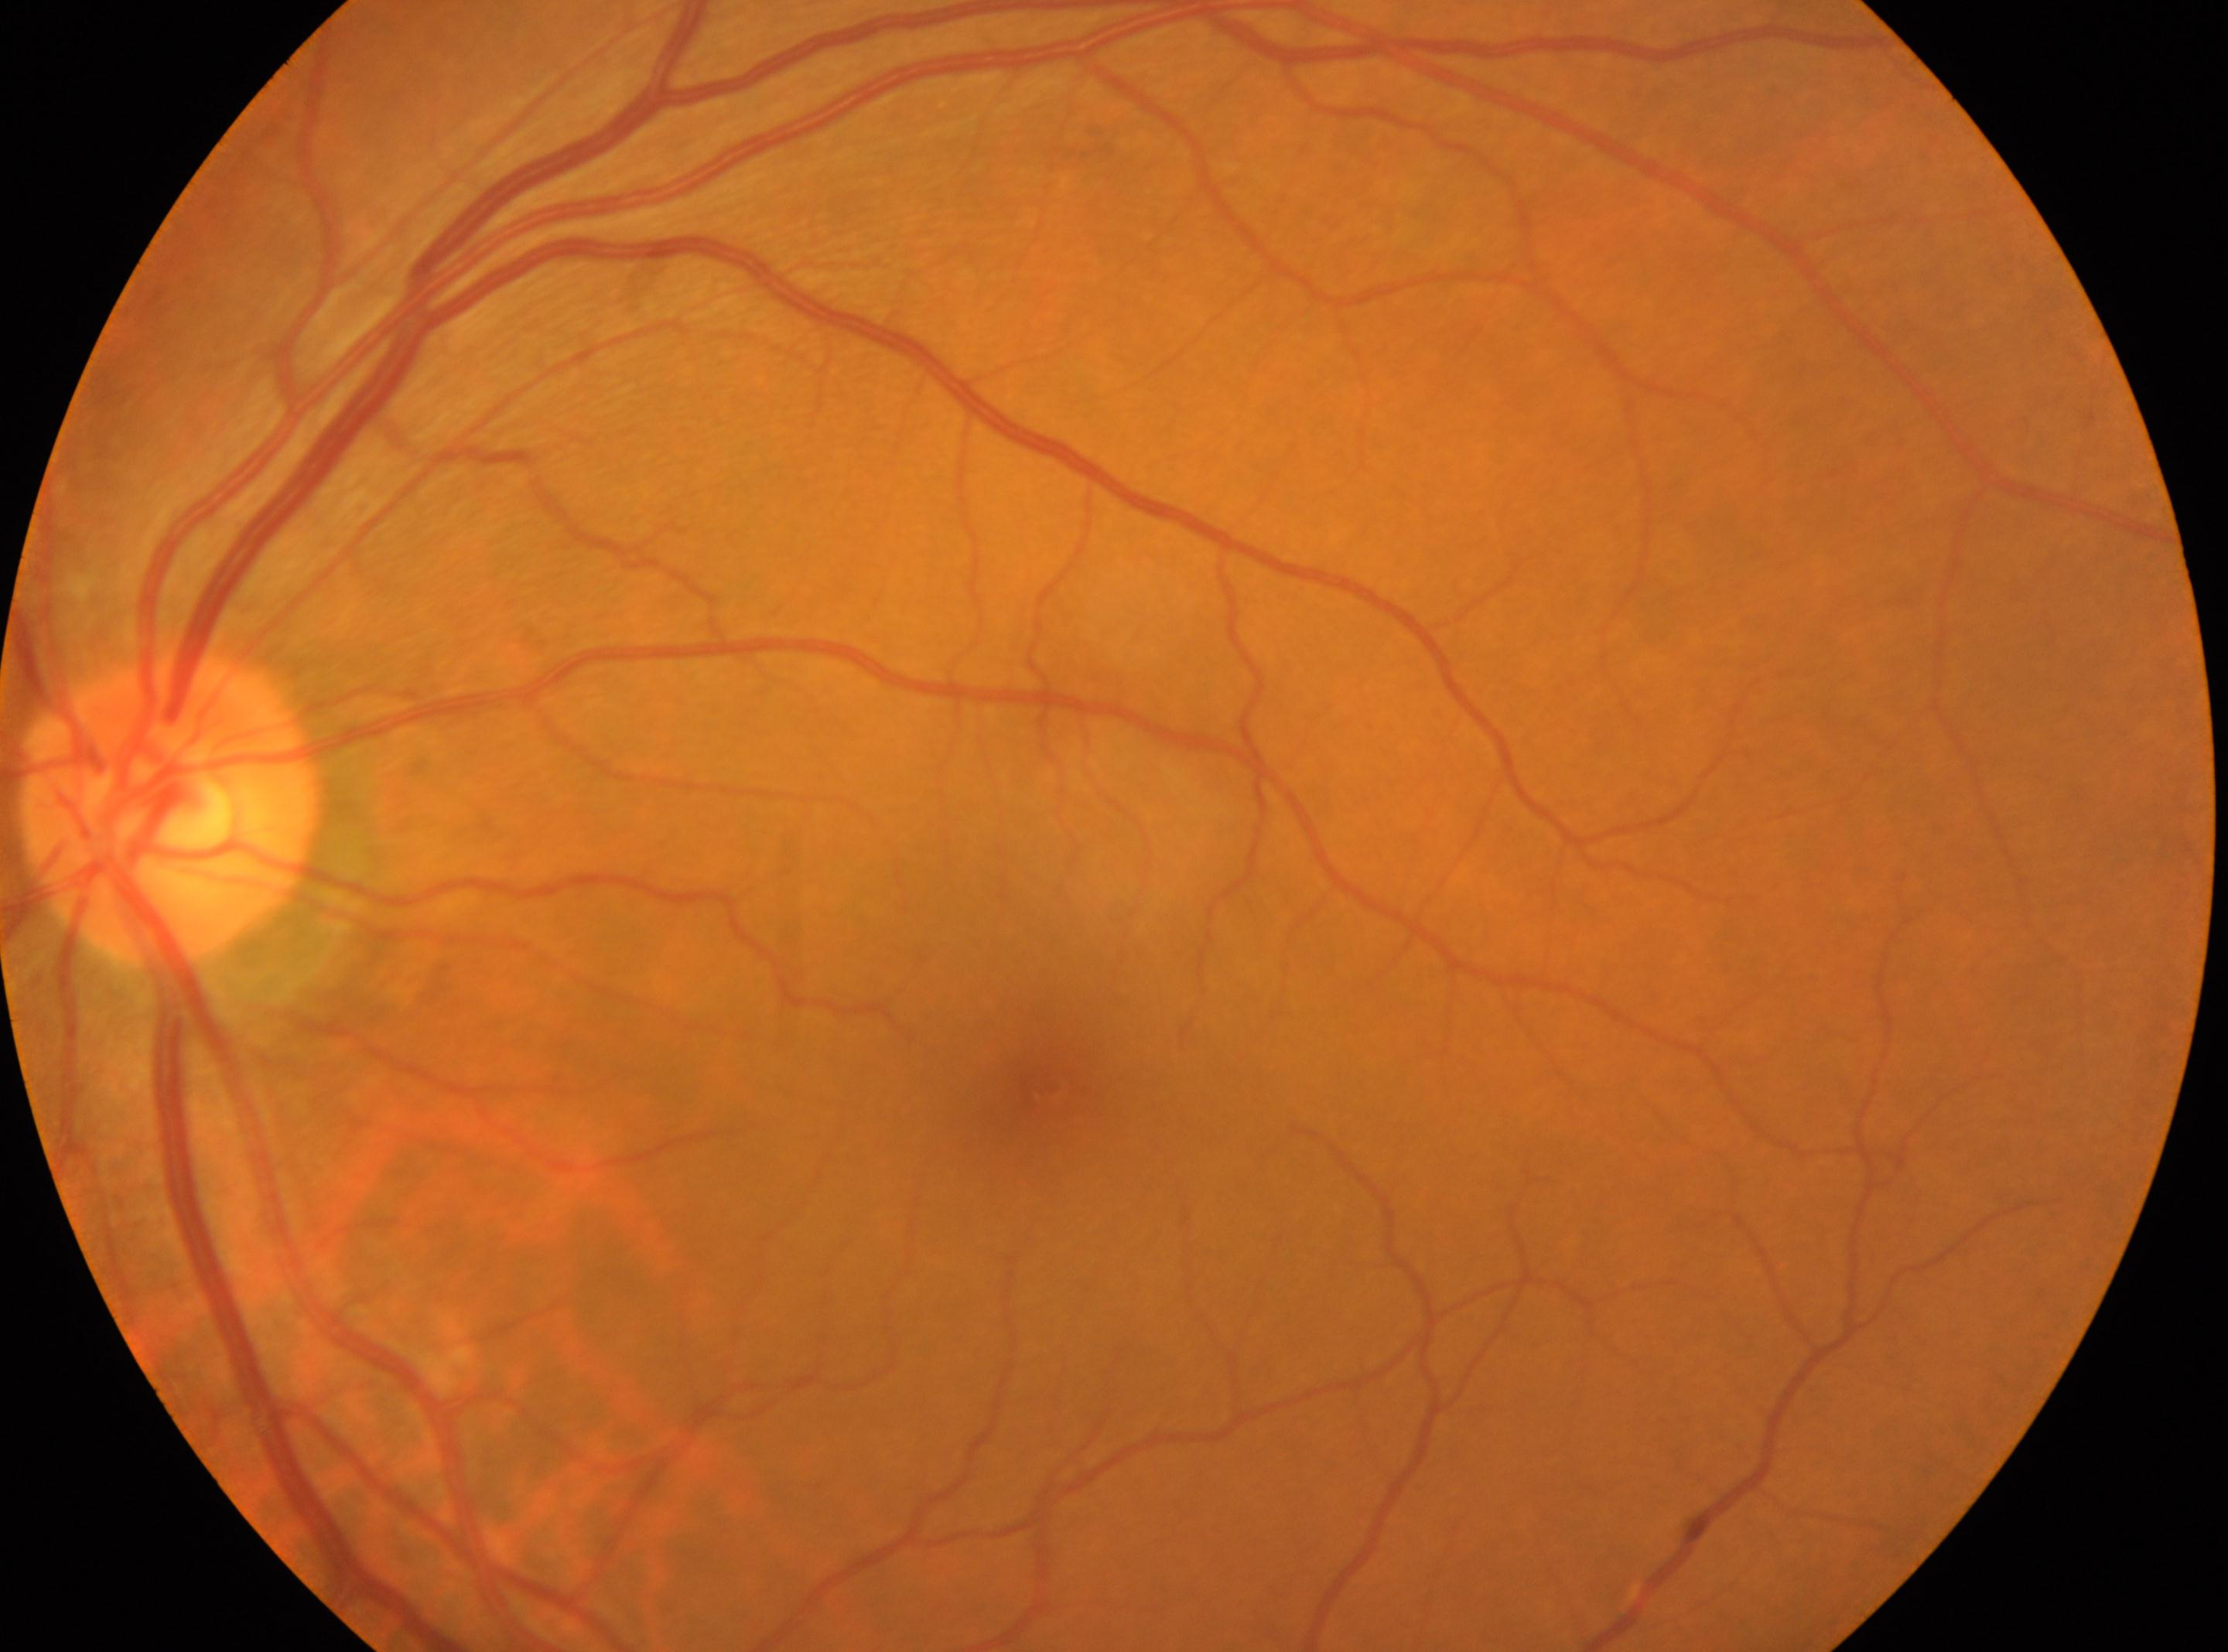

No diabetic retinal disease findings.
This is the left eye.
Optic disc located at (x: 170, y: 812).
Macula center located at (x: 1046, y: 1087).
Retinopathy grade: 0.